Davis DR grading, 848x848 — 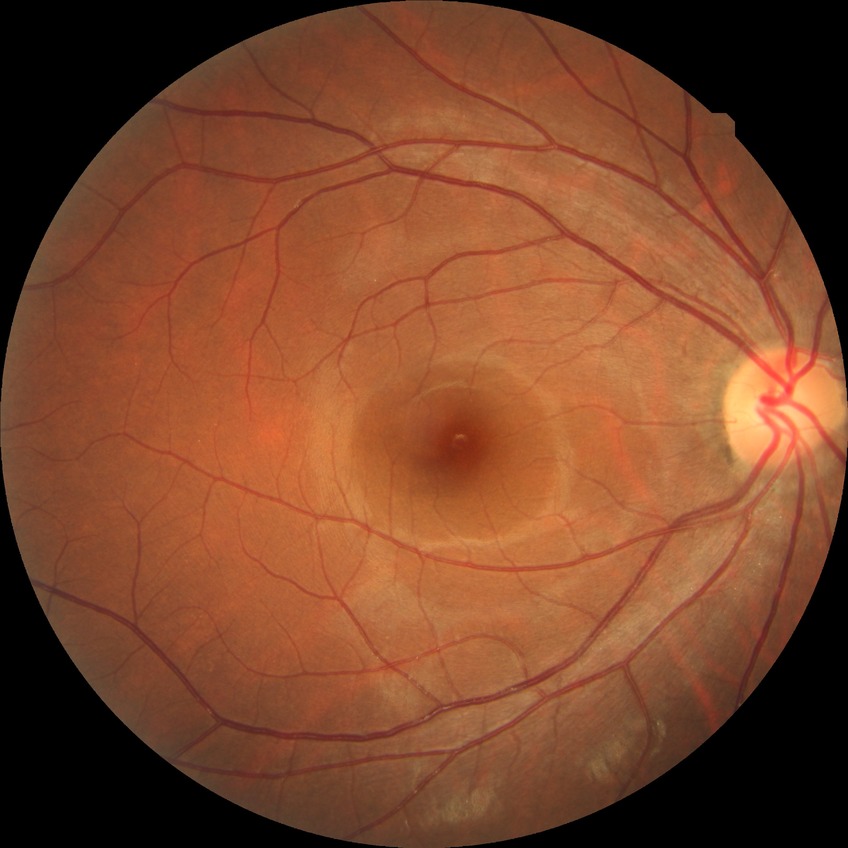
diabetic retinopathy (DR) = NDR (no diabetic retinopathy).